Fundus photo, 45° FOV
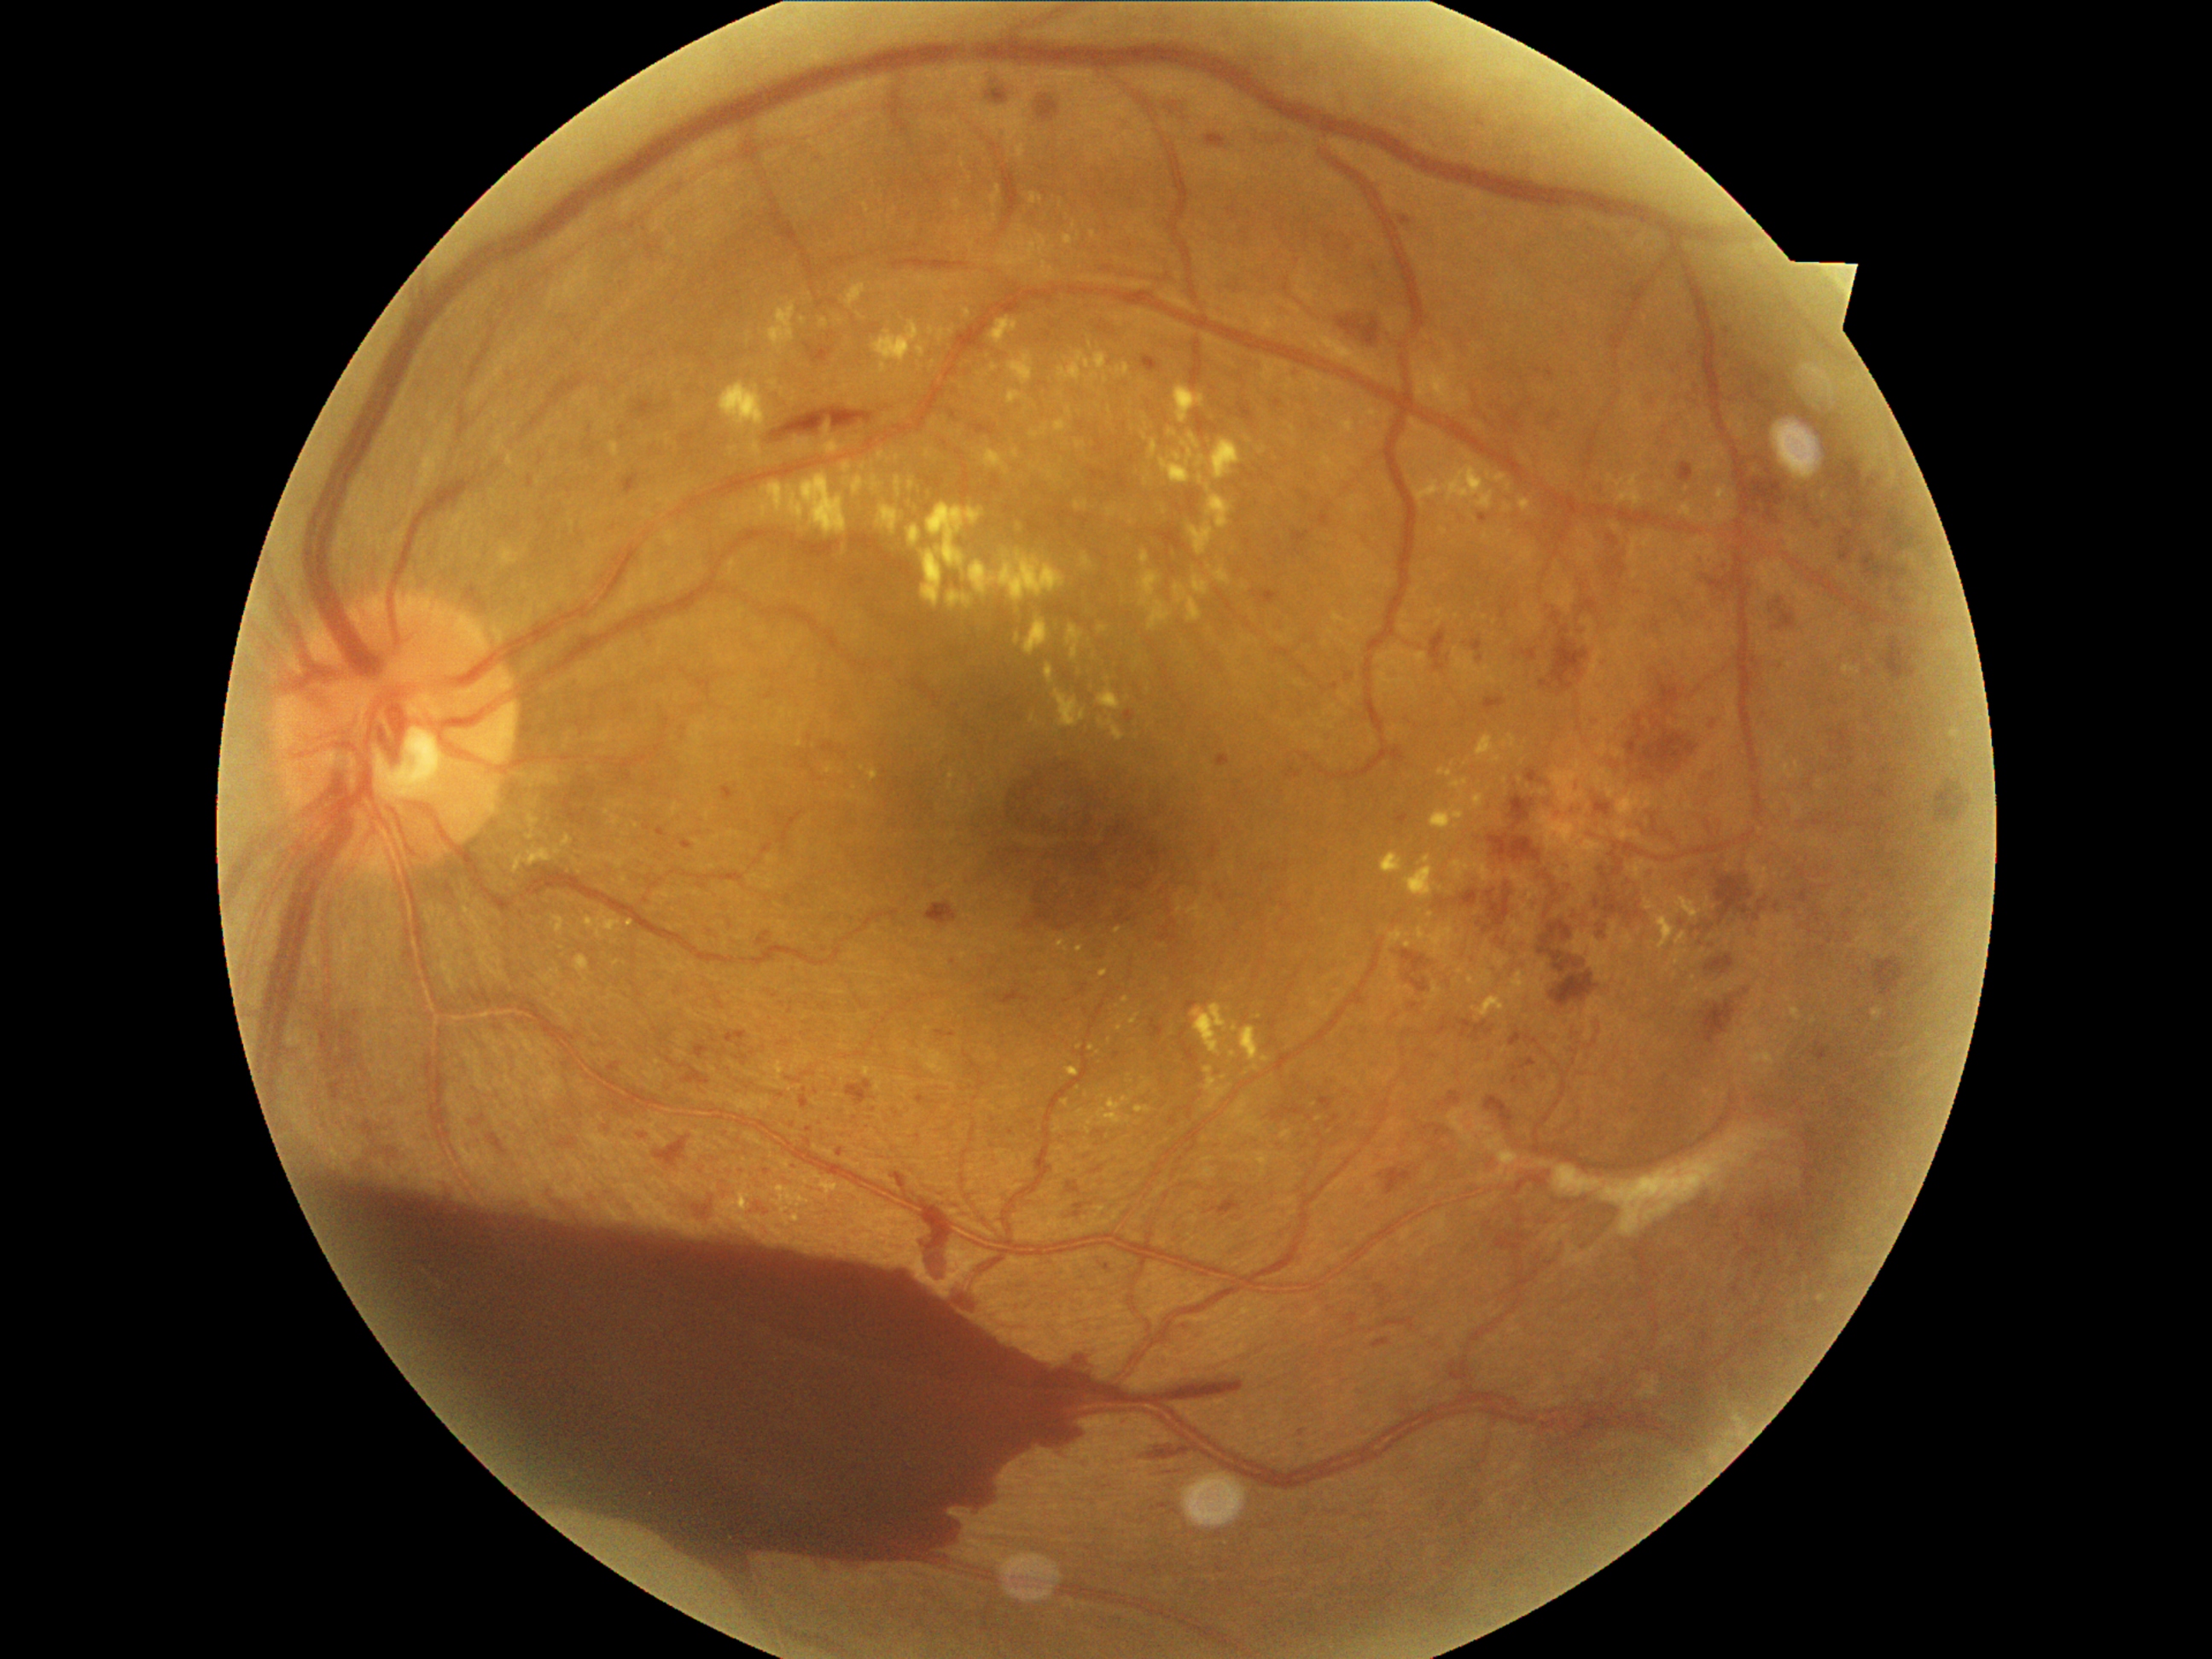

Diabetic retinopathy grade is 4/4
Selected lesions:
hard exudates (subset): region(846, 284, 868, 308) | region(965, 310, 972, 320) | region(585, 909, 622, 940) | region(1192, 1003, 1230, 1056) | region(1615, 480, 1626, 489) | region(1791, 1006, 1803, 1022) | region(1117, 315, 1126, 327) | region(559, 839, 573, 847) | region(1214, 566, 1231, 586) | region(977, 448, 1010, 474) | region(1243, 637, 1254, 643) | region(1680, 503, 1694, 520) | region(610, 443, 620, 457)
Hard exudates (small, approximate centers) near {"x": 1390, "y": 989} | {"x": 1264, "y": 451} | {"x": 1140, "y": 1123} | {"x": 1702, "y": 521} | {"x": 898, "y": 457} | {"x": 934, "y": 362}